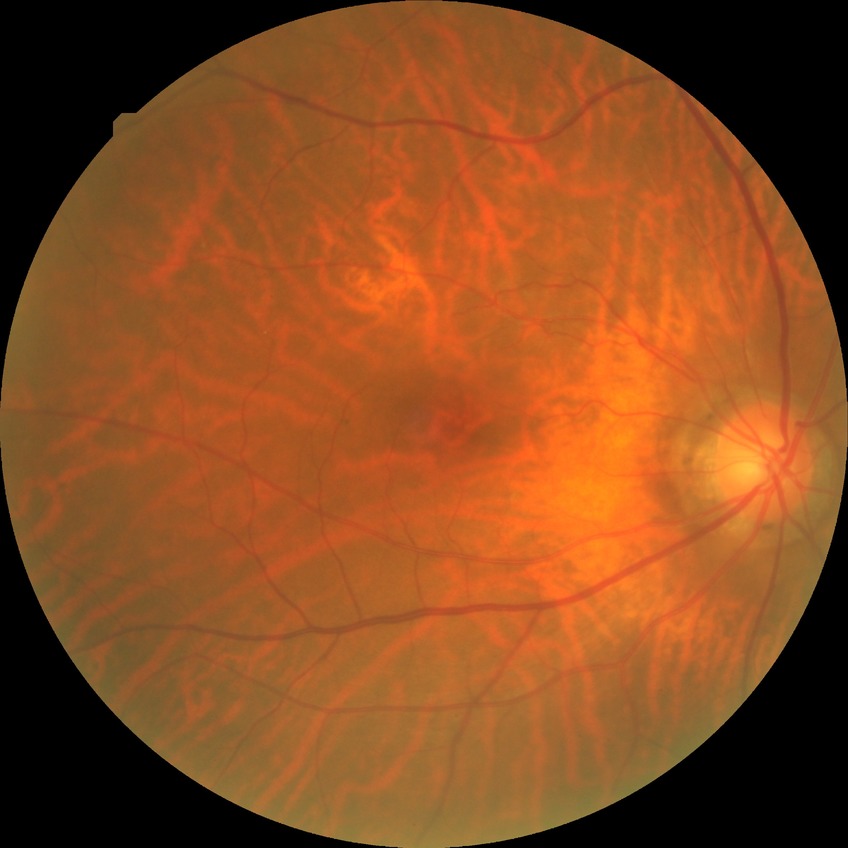
Modified Davis grading: no diabetic retinopathy.